Image size 1240x1240. Pediatric retinal photograph (wide-field). Phoenix ICON, 100° FOV — 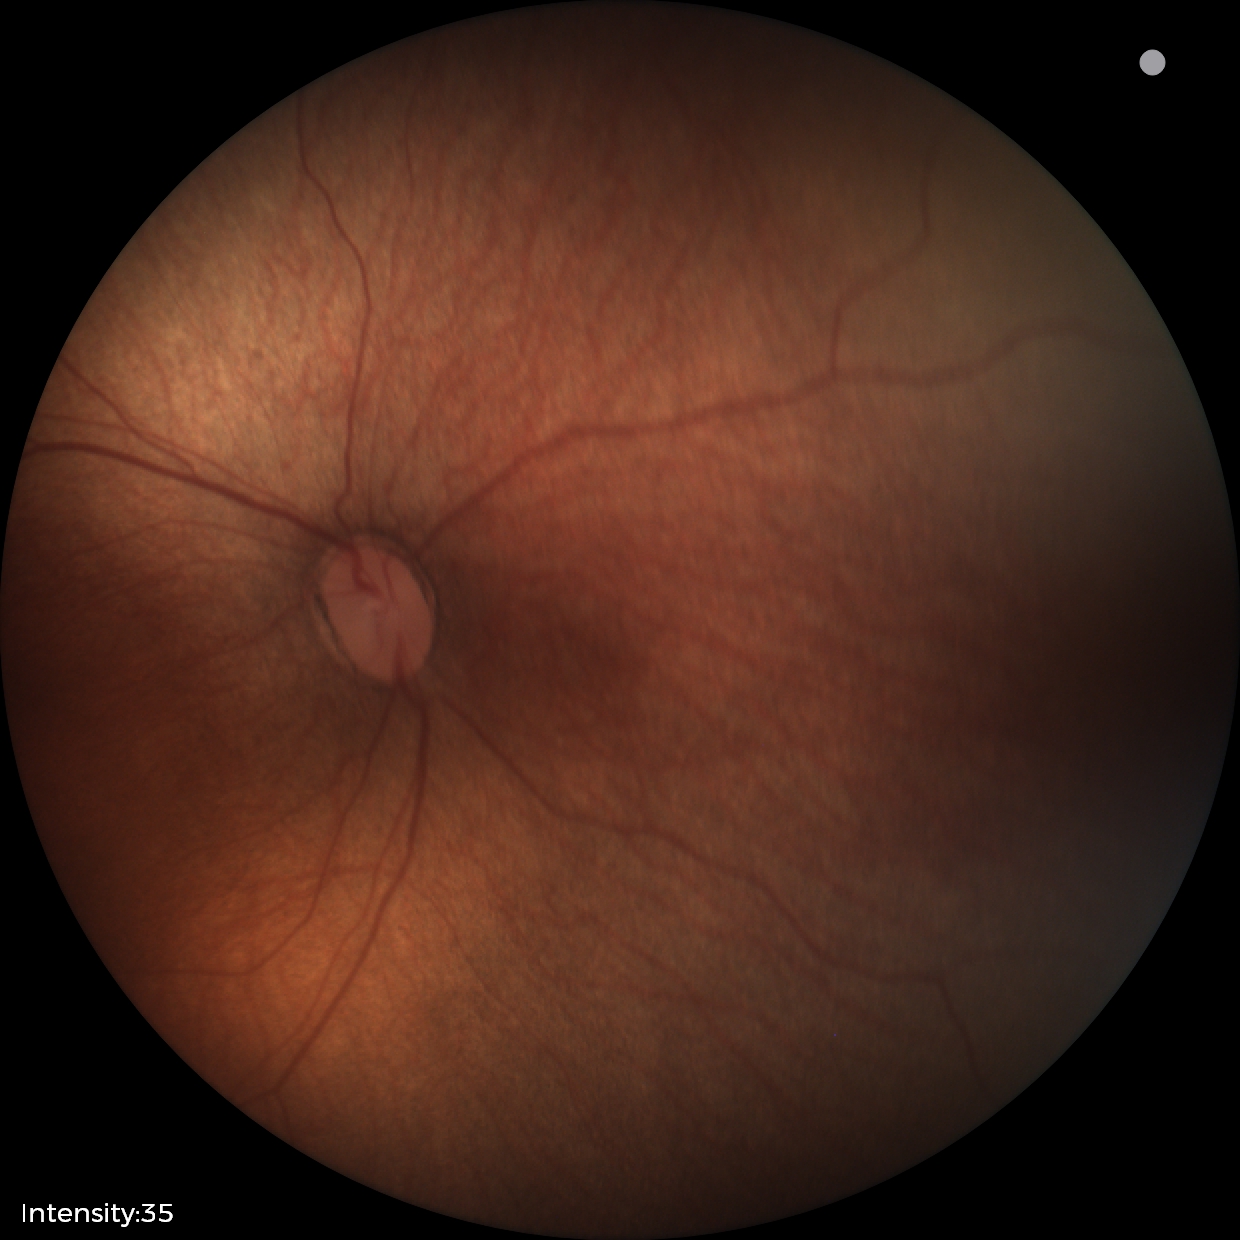
Examination diagnosed as status post ROP.